Wide-field fundus photograph of an infant. 1240 by 1240 pixels. Phoenix ICON, 100° FOV
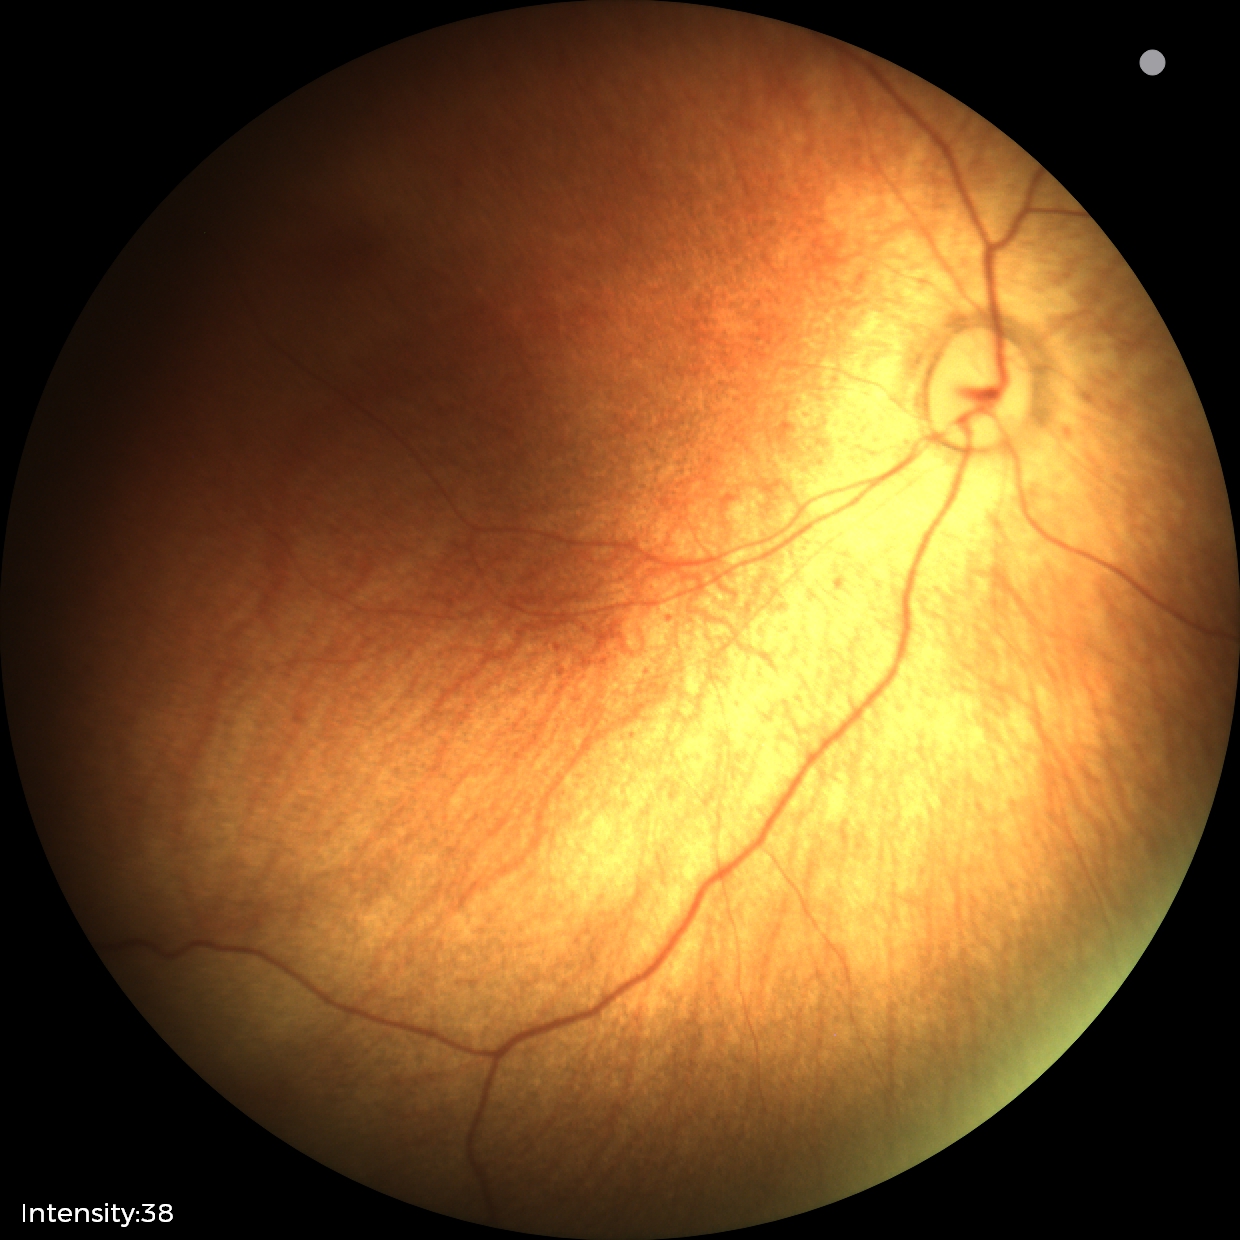
Screening examination with no abnormal retinal findings.